NIDEK AFC-230.
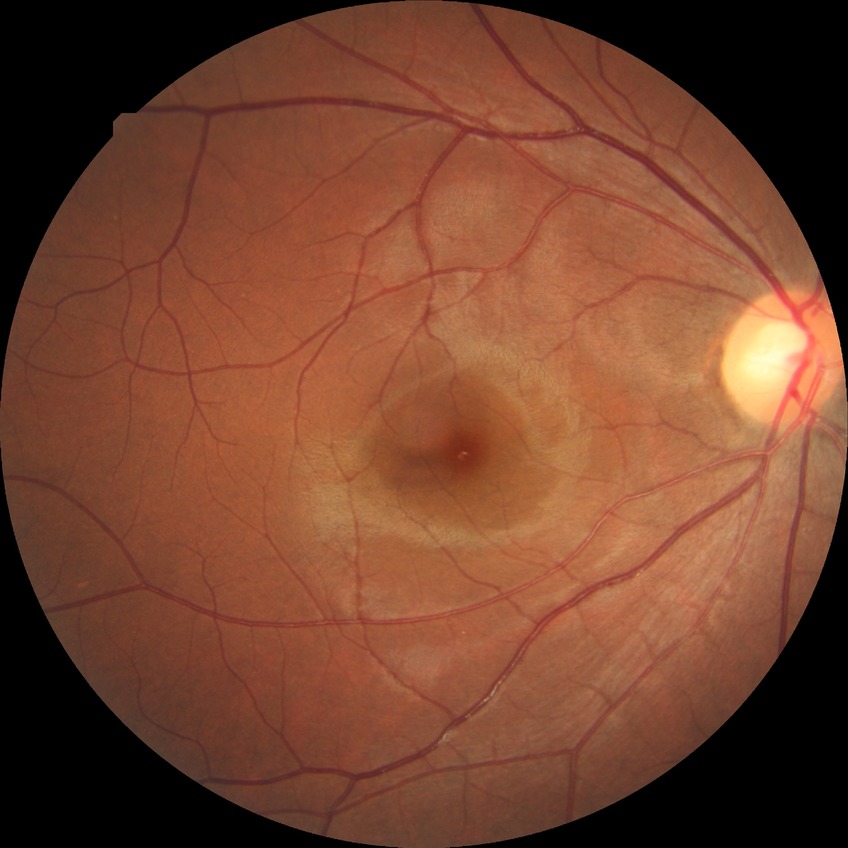

Diabetic retinopathy (DR): no diabetic retinopathy (NDR).